Pediatric wide-field fundus photograph
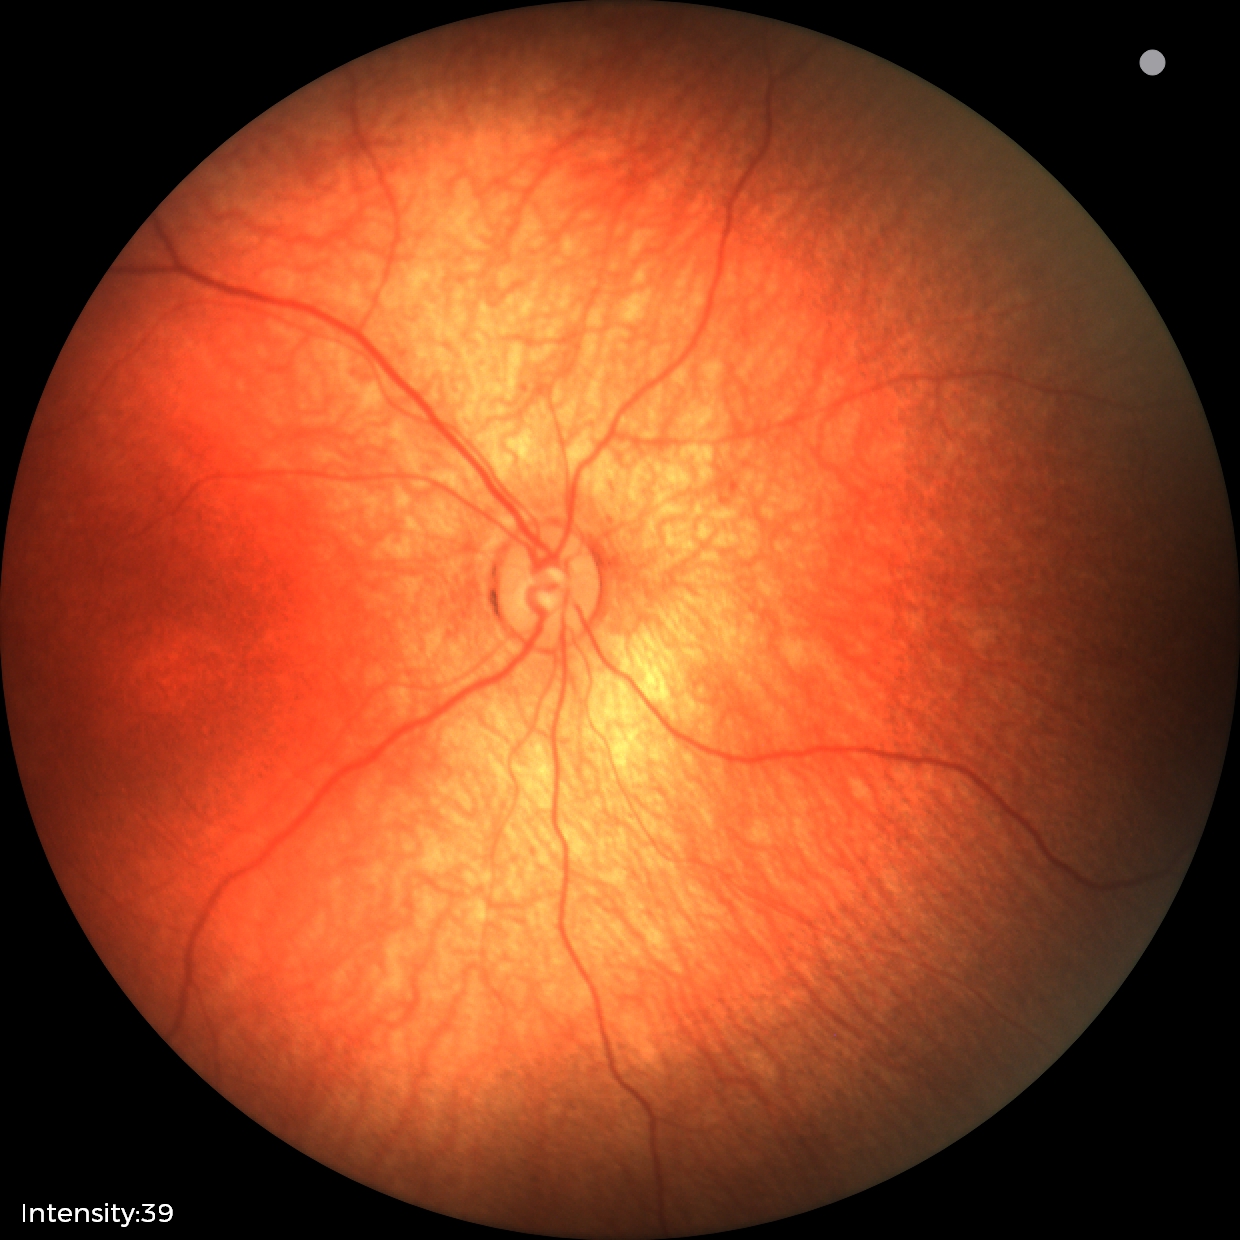

Examination with physiological retinal findings.